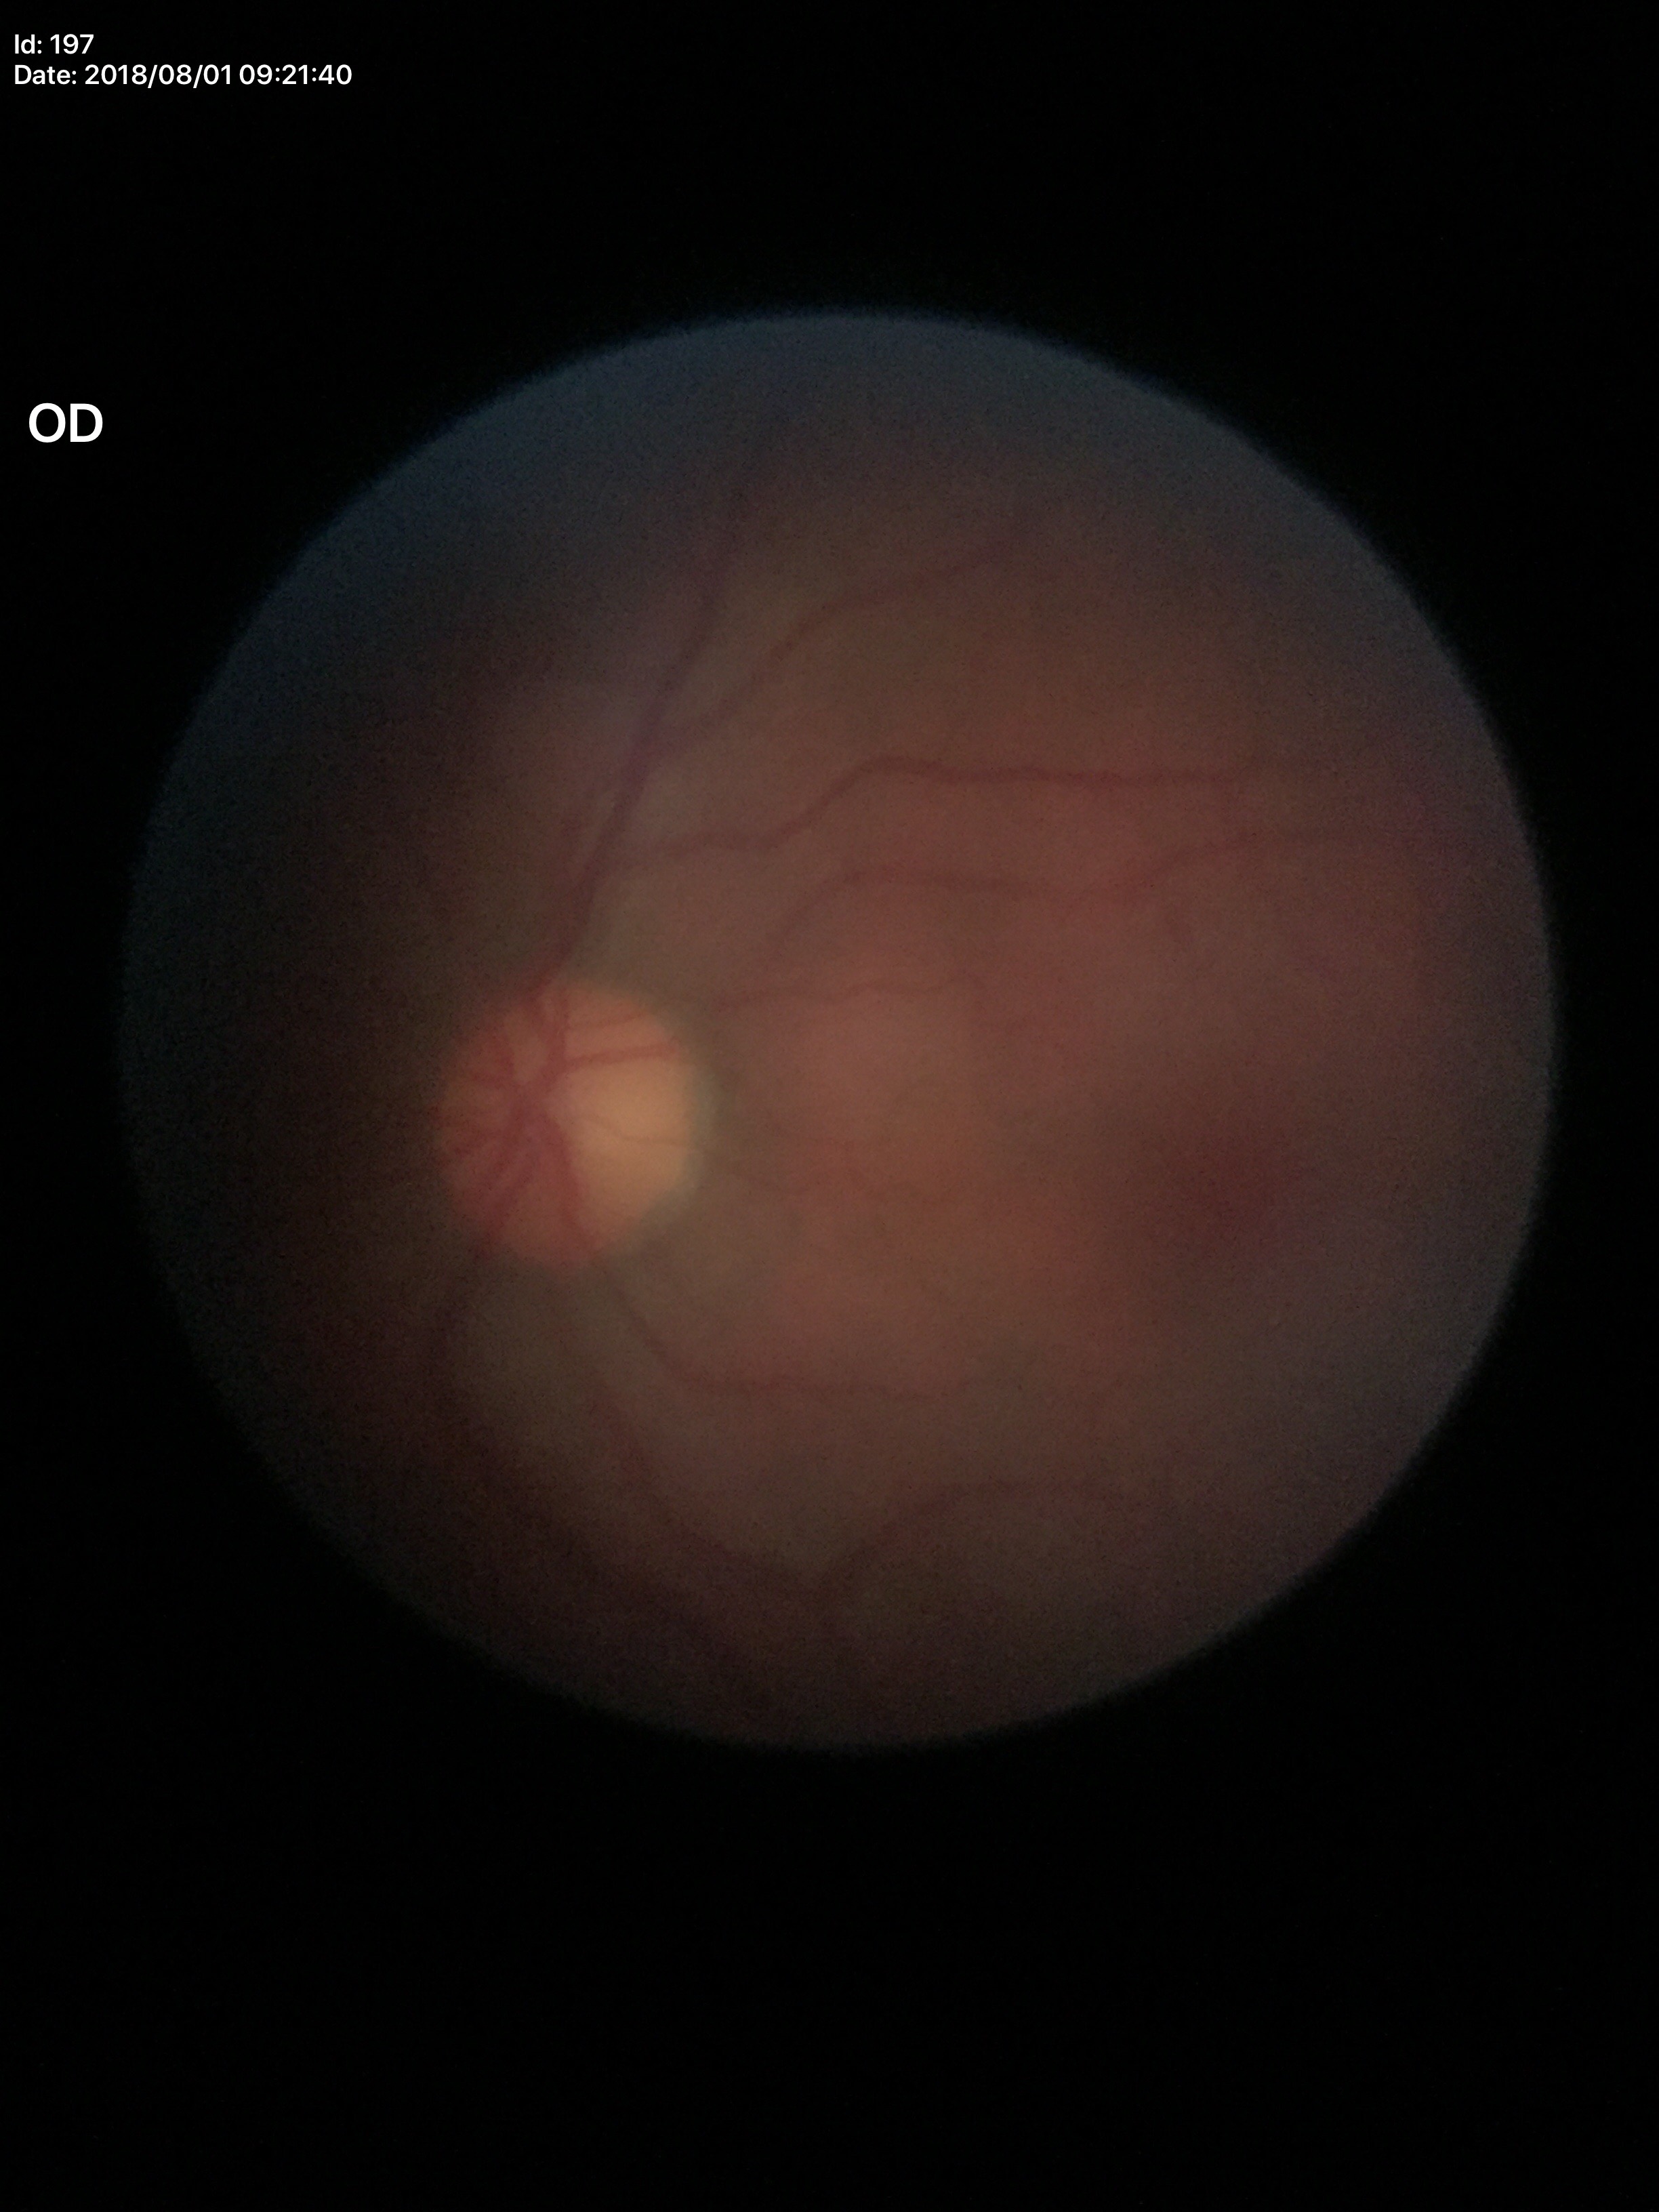

Glaucoma decision: no suspicious findings.
Vertical cup-to-disc ratio: 0.45.